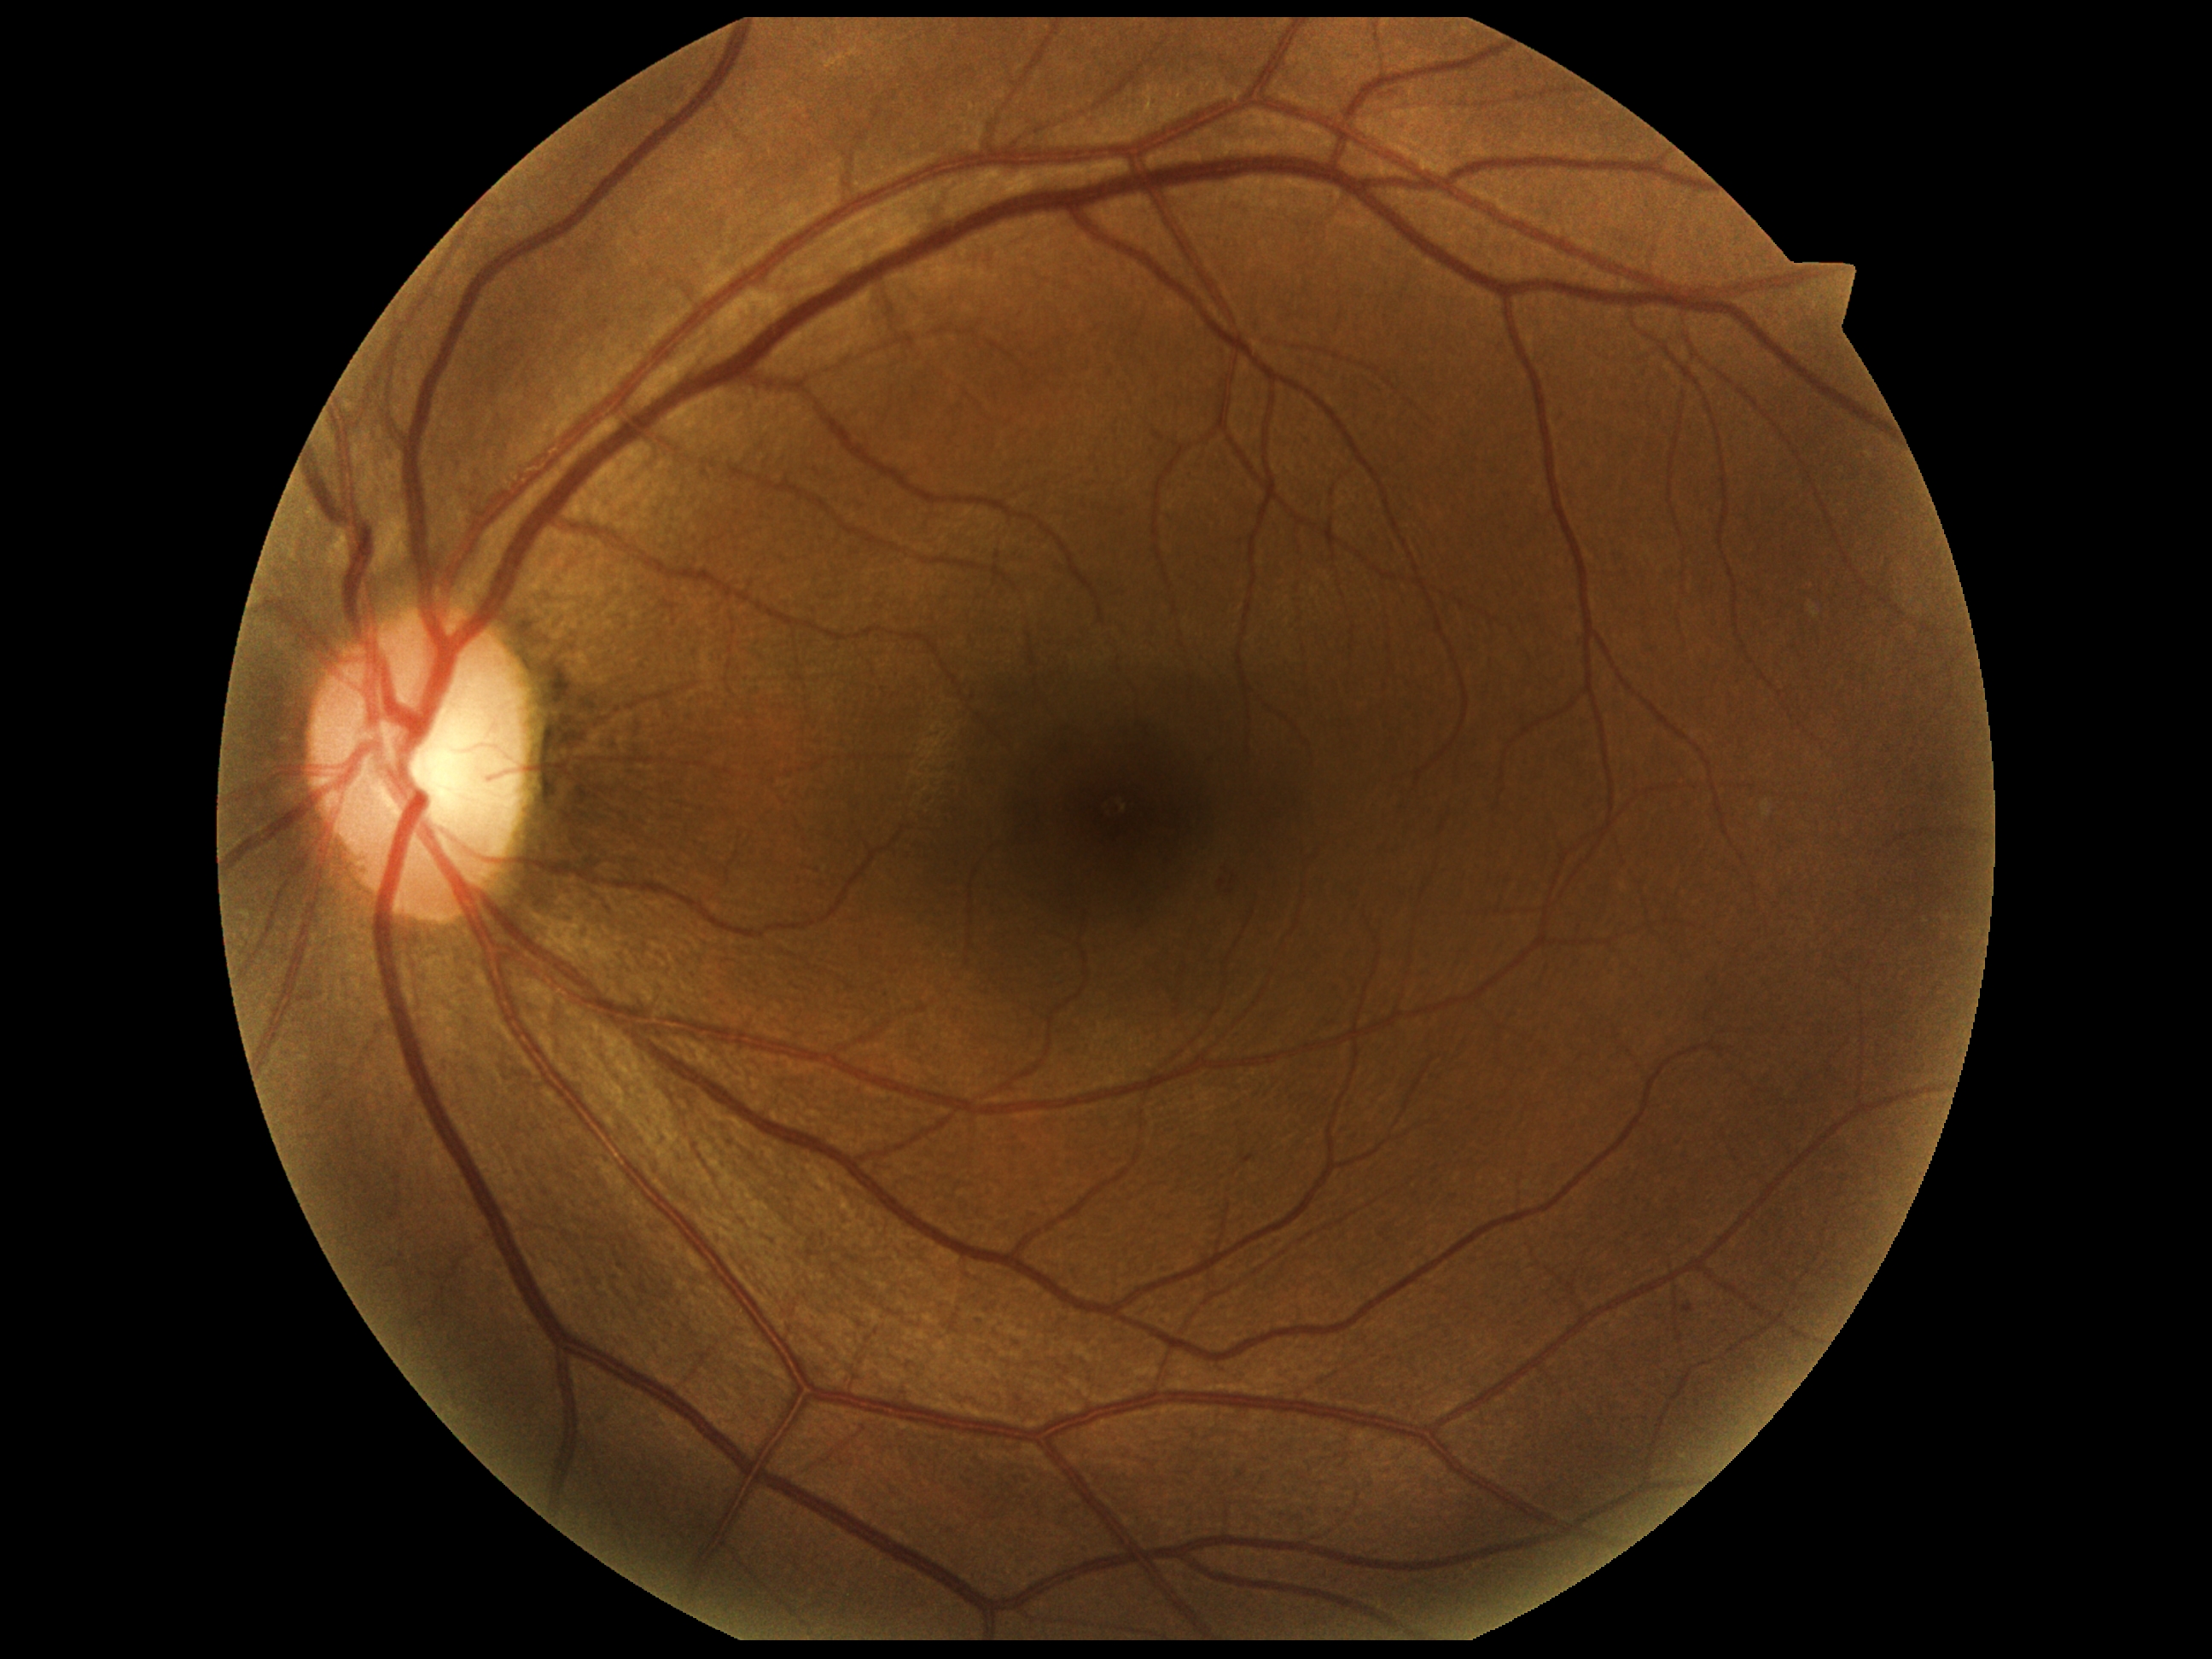
Annotations:
• DR class — non-proliferative diabetic retinopathy
• diabetic retinopathy (DR) — 2/4